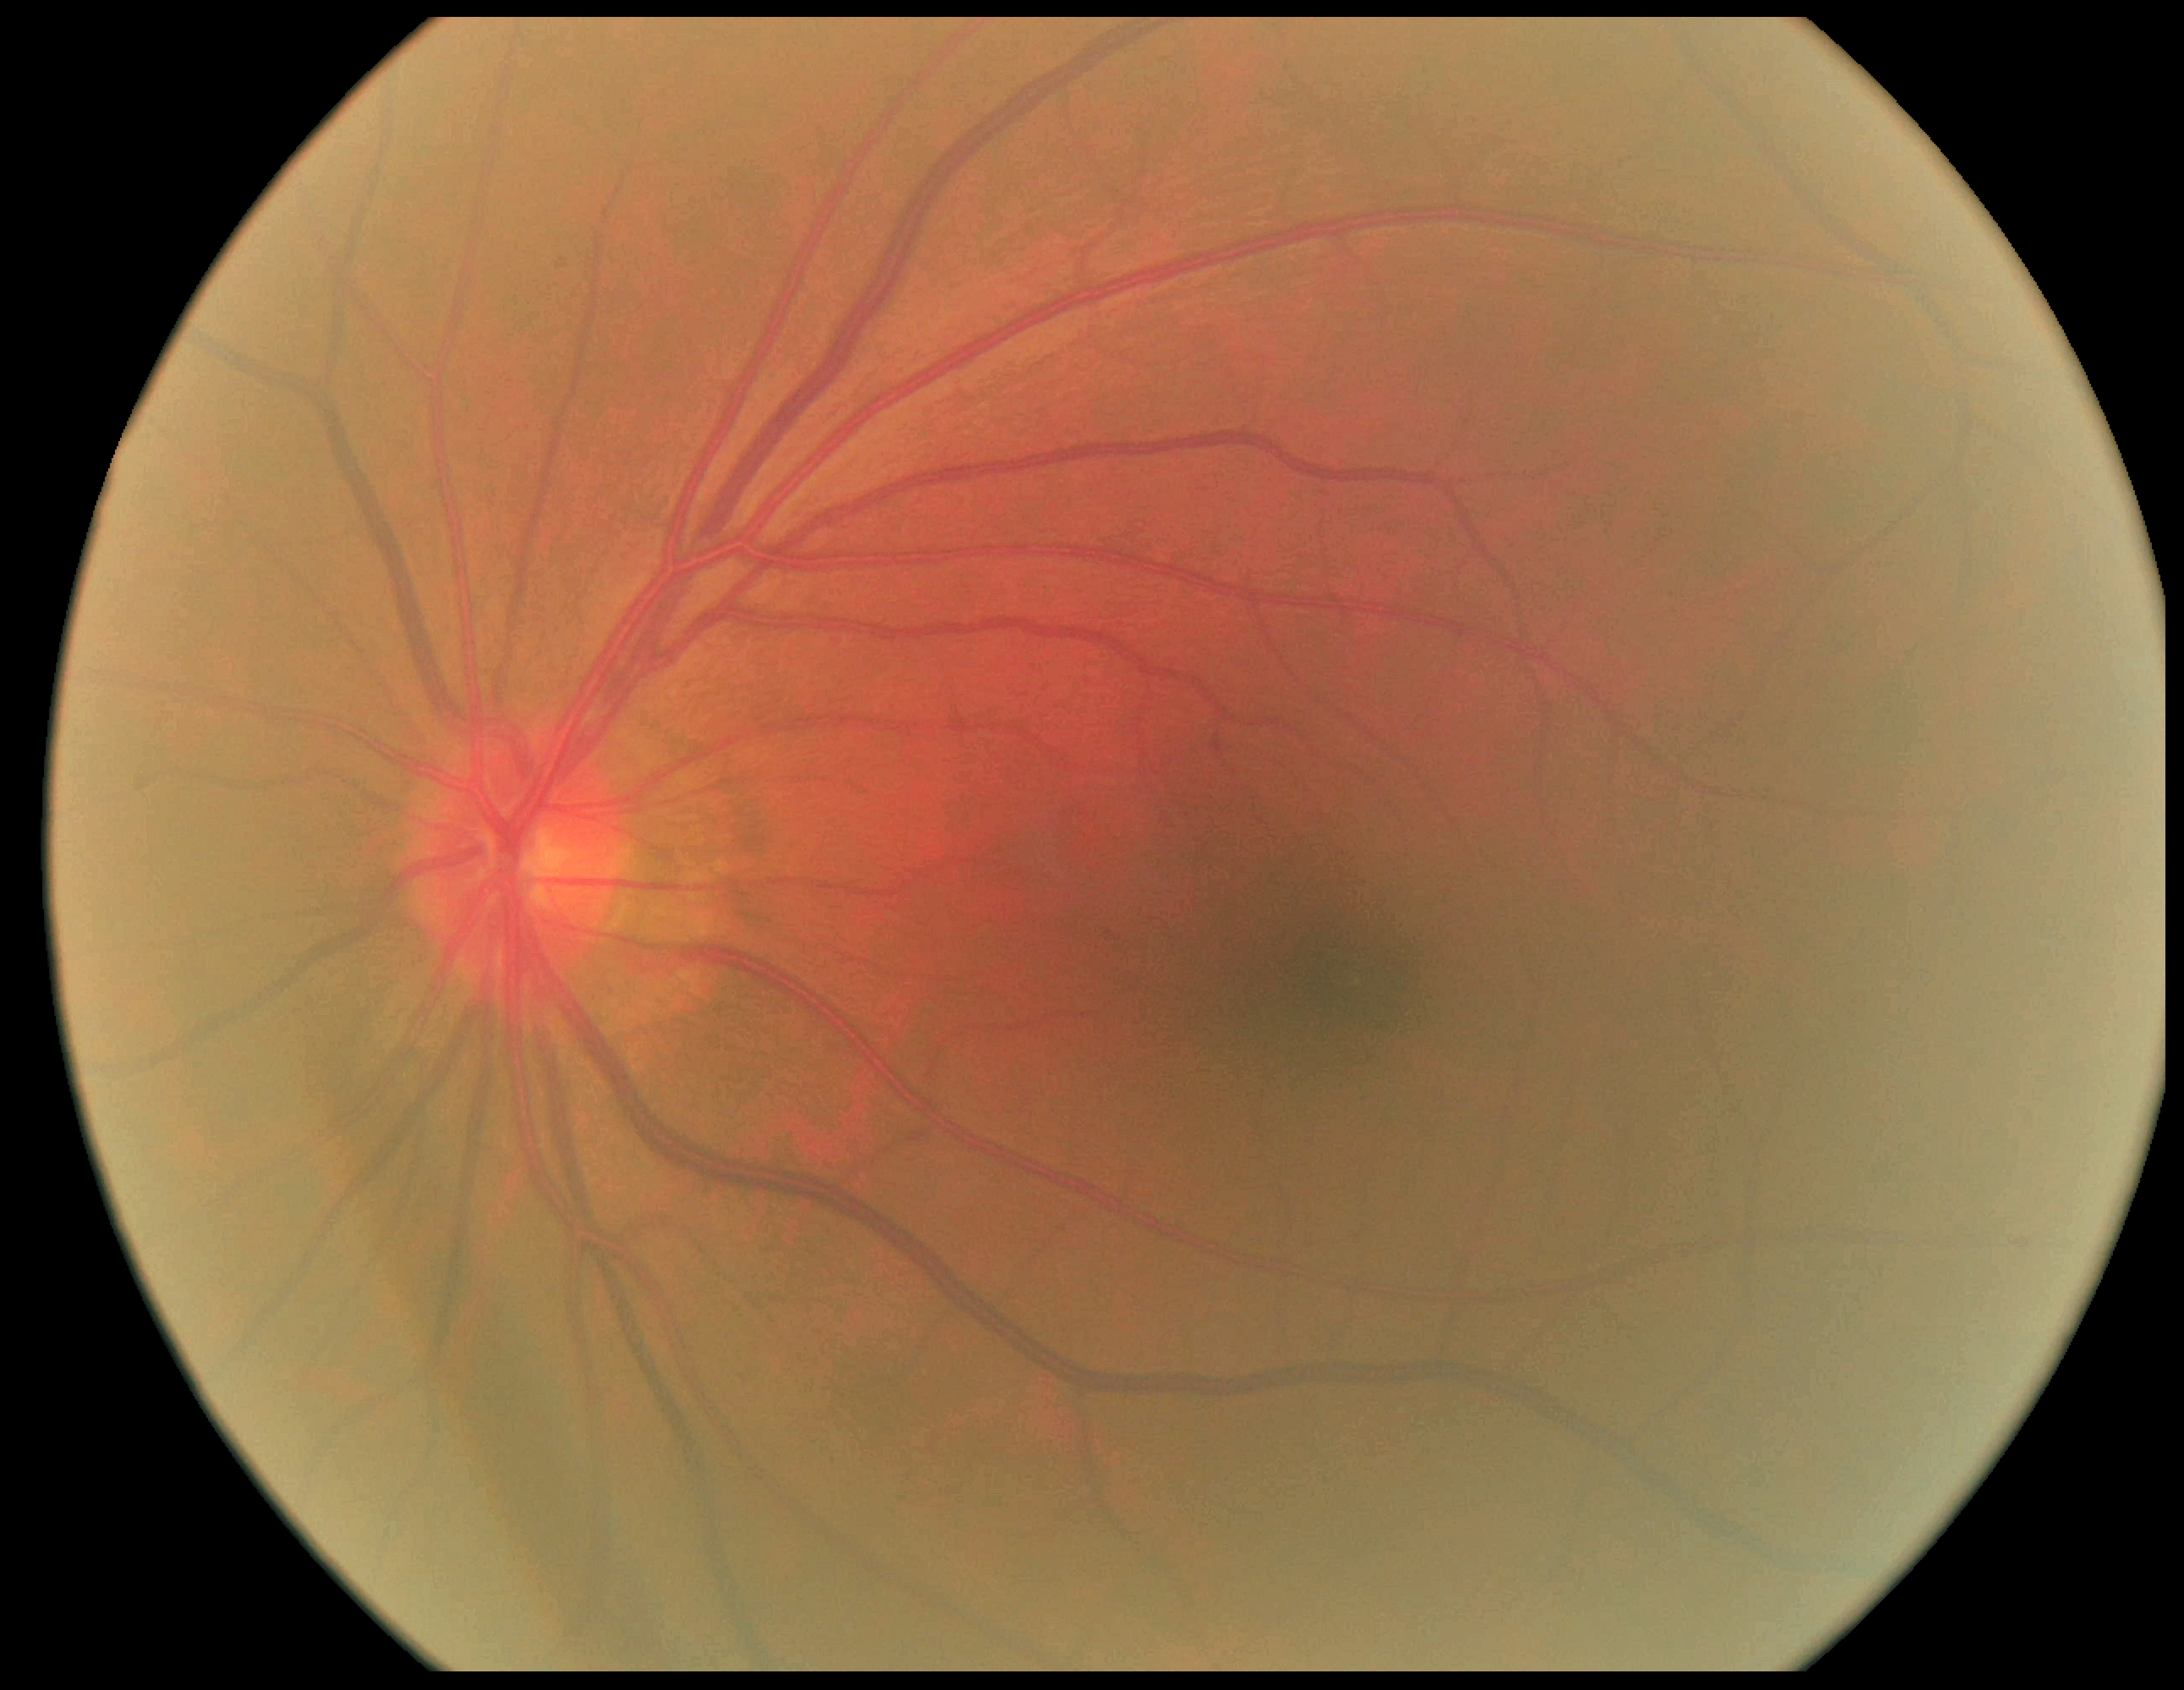

Diabetic retinopathy (DR): grade 0 (no apparent retinopathy).